Color fundus photograph centered on the optic disc: 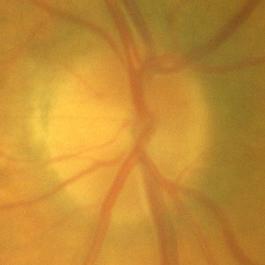
No glaucomatous optic neuropathy.